Modified Davis grading, nonmydriatic fundus photograph, NIDEK AFC-230 fundus camera — 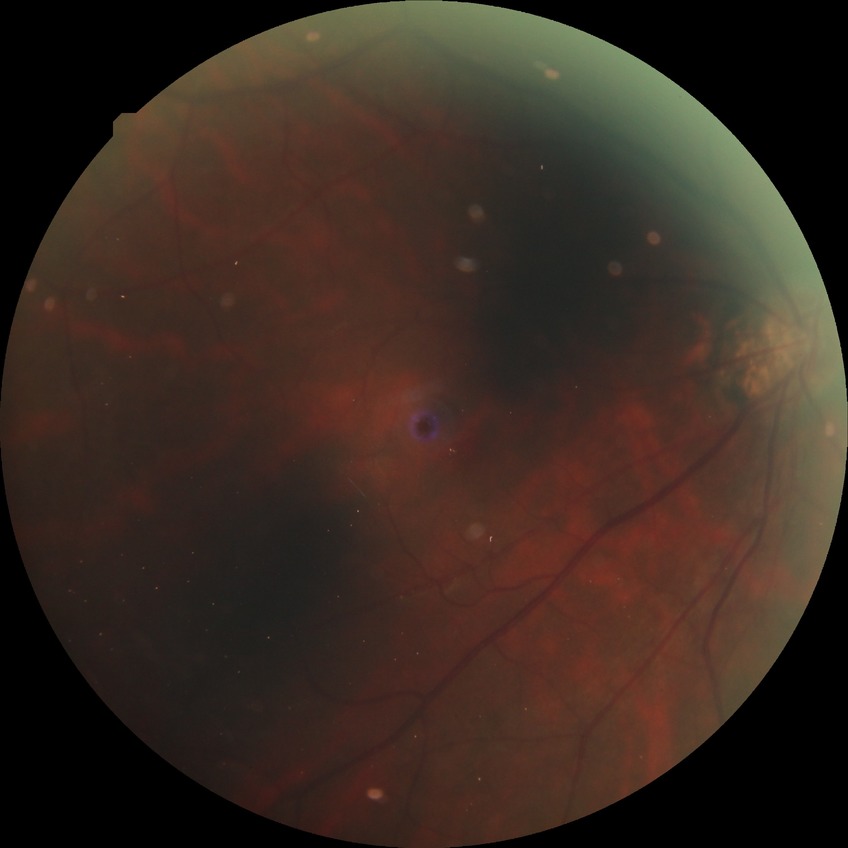
DR grade is NDR.